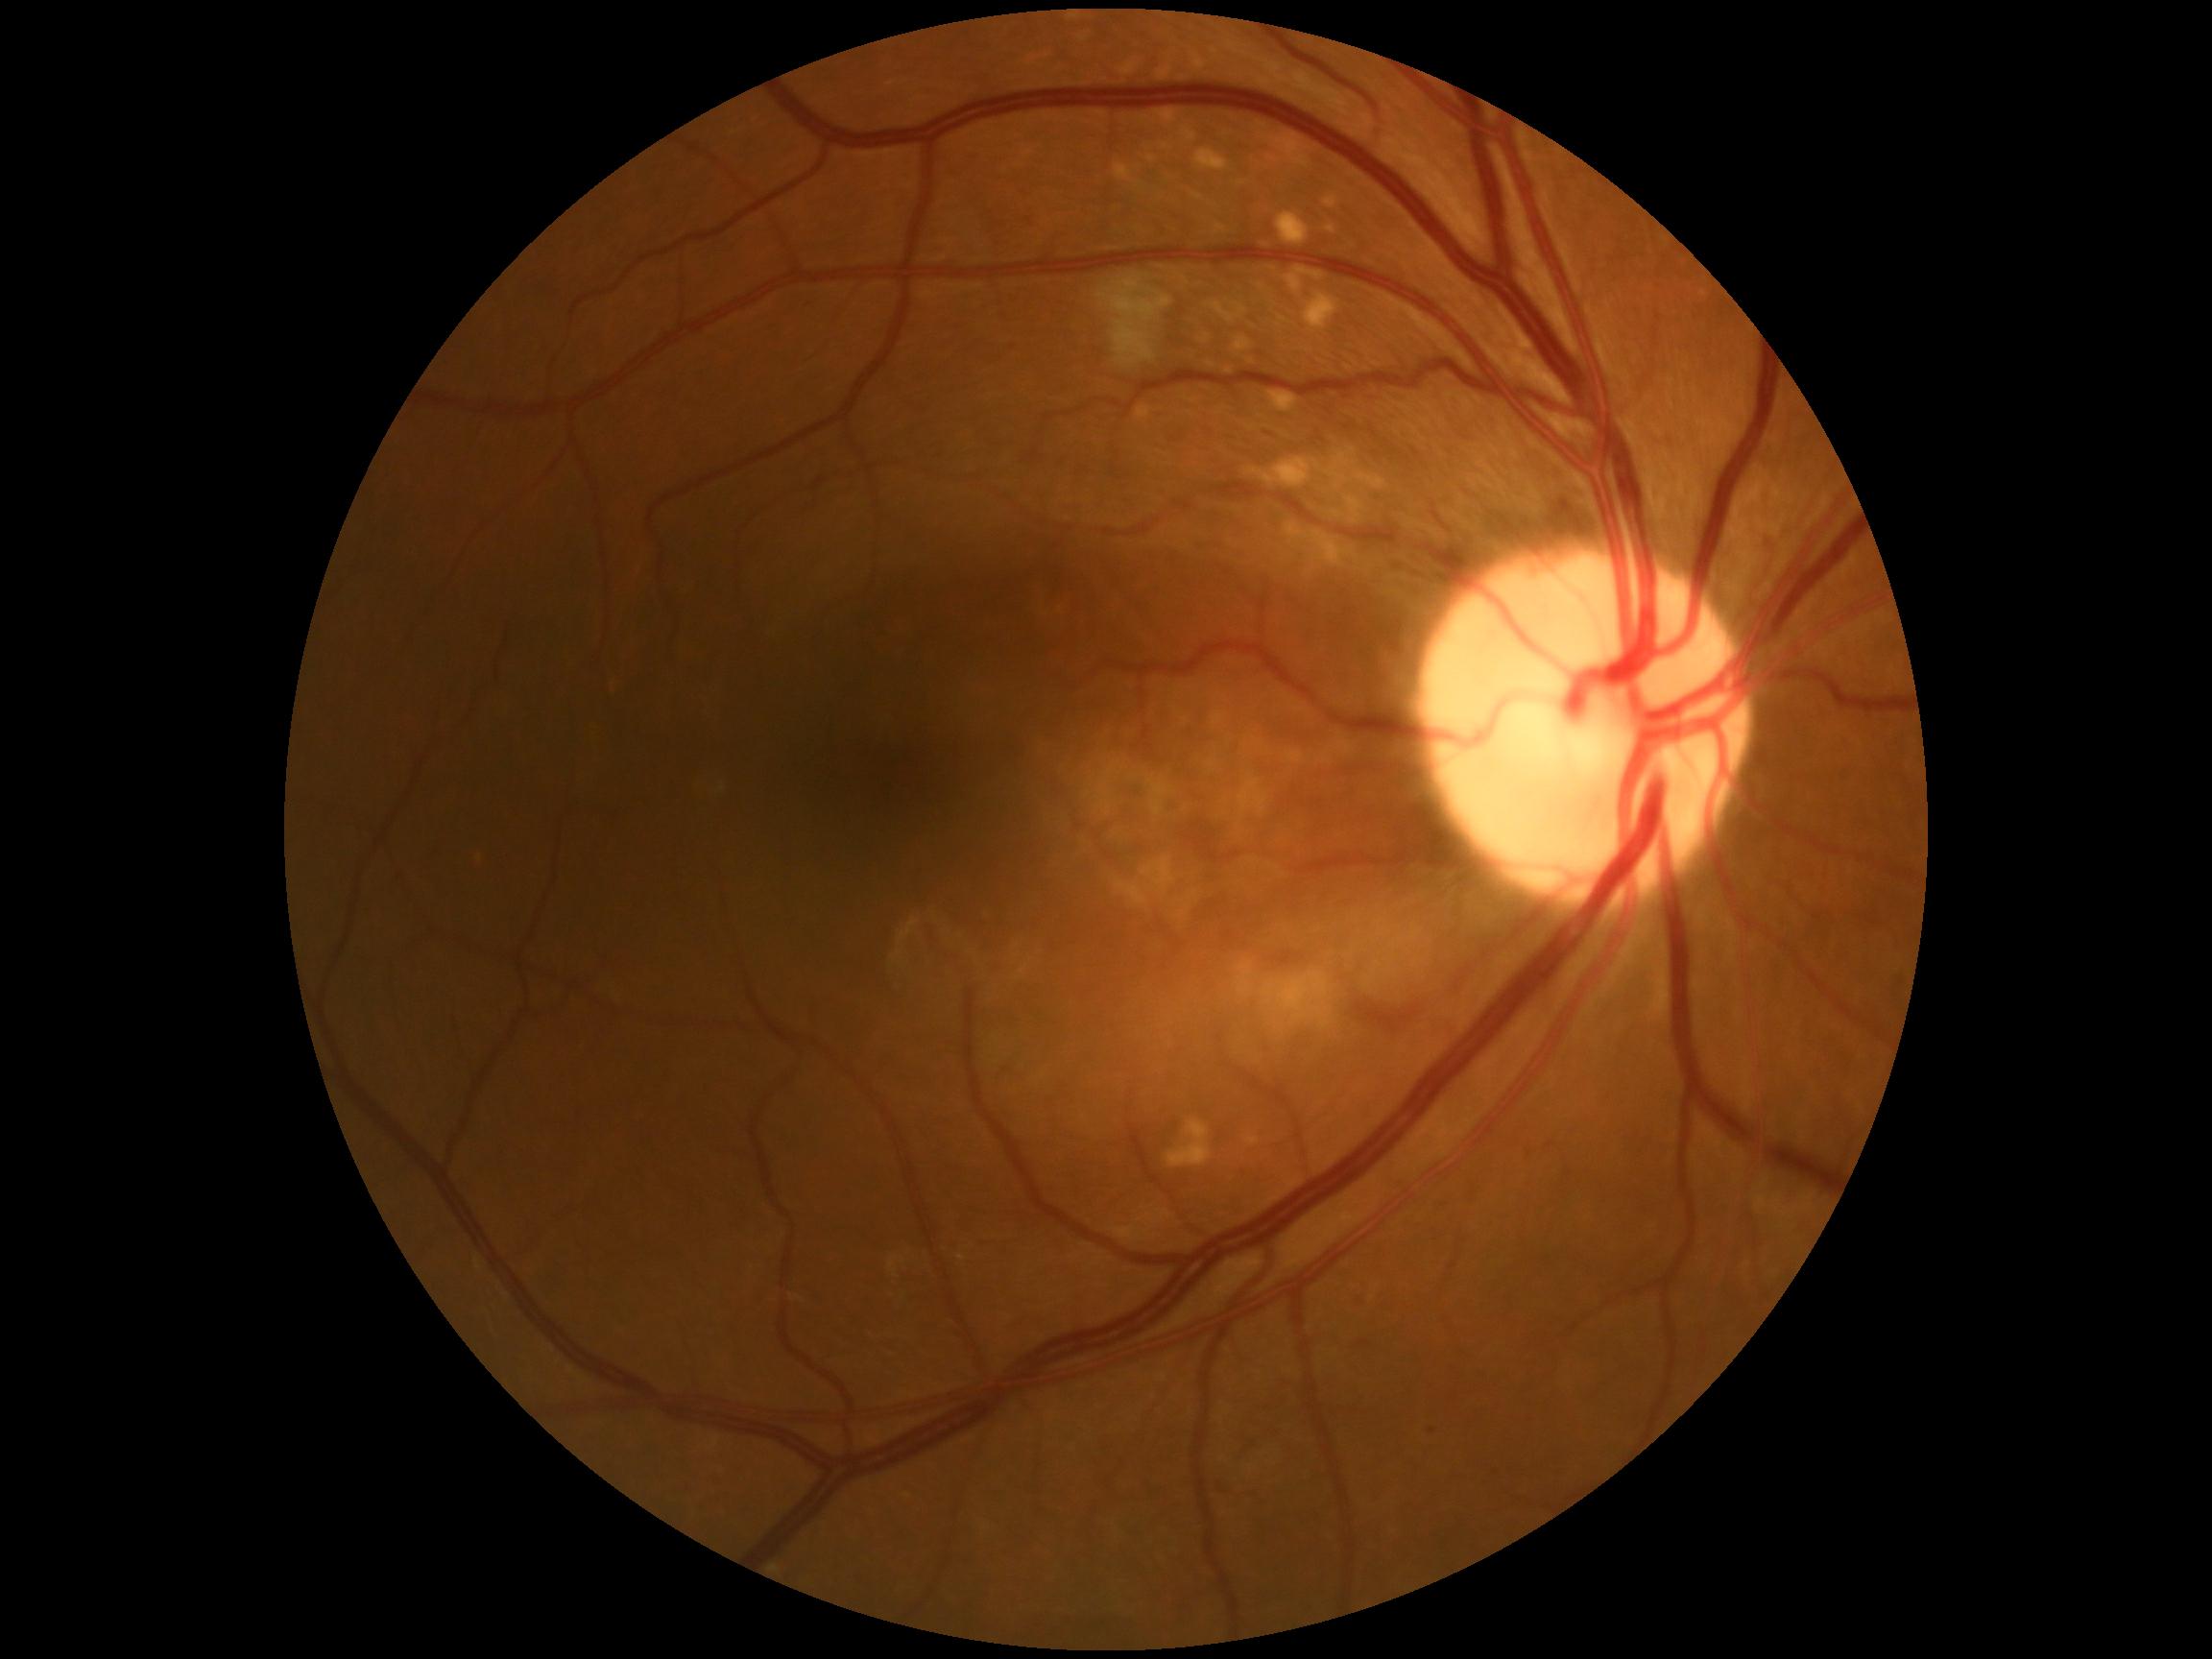
DR grade: 2.